1659x2212
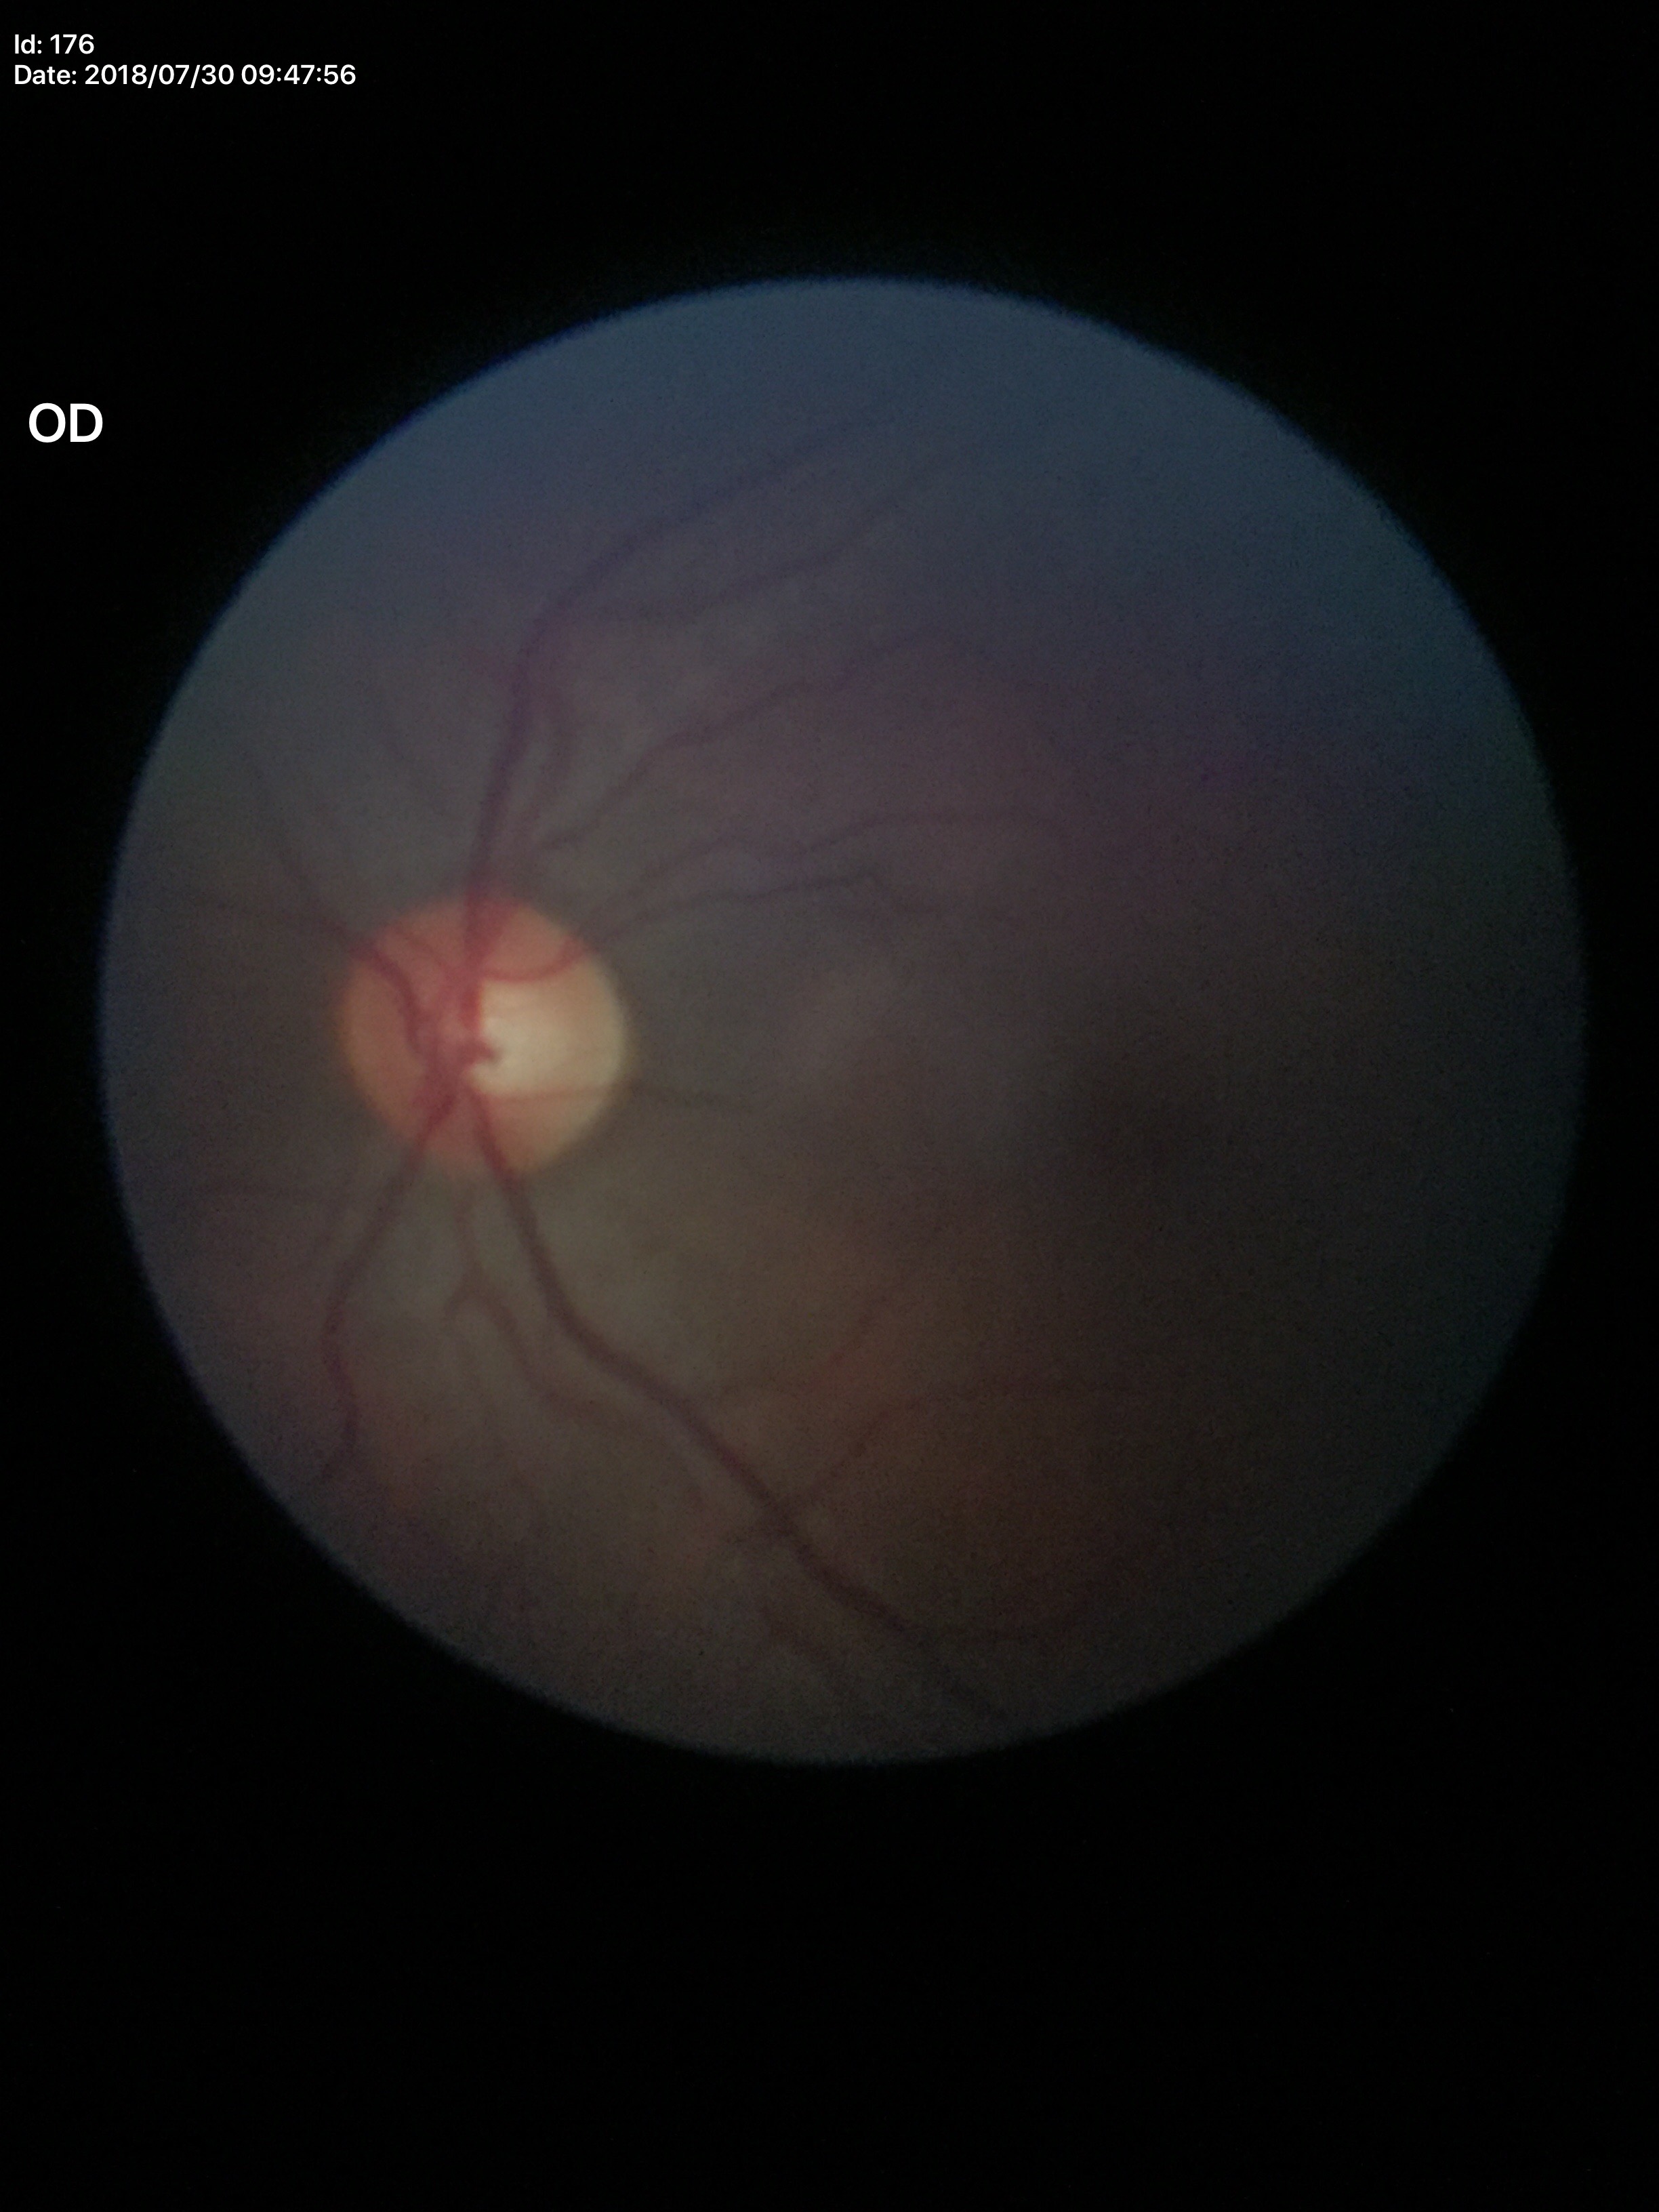

No signs of glaucoma. Vertical C/D ratio of 0.49. Area cup-to-disc ratio is 0.29.